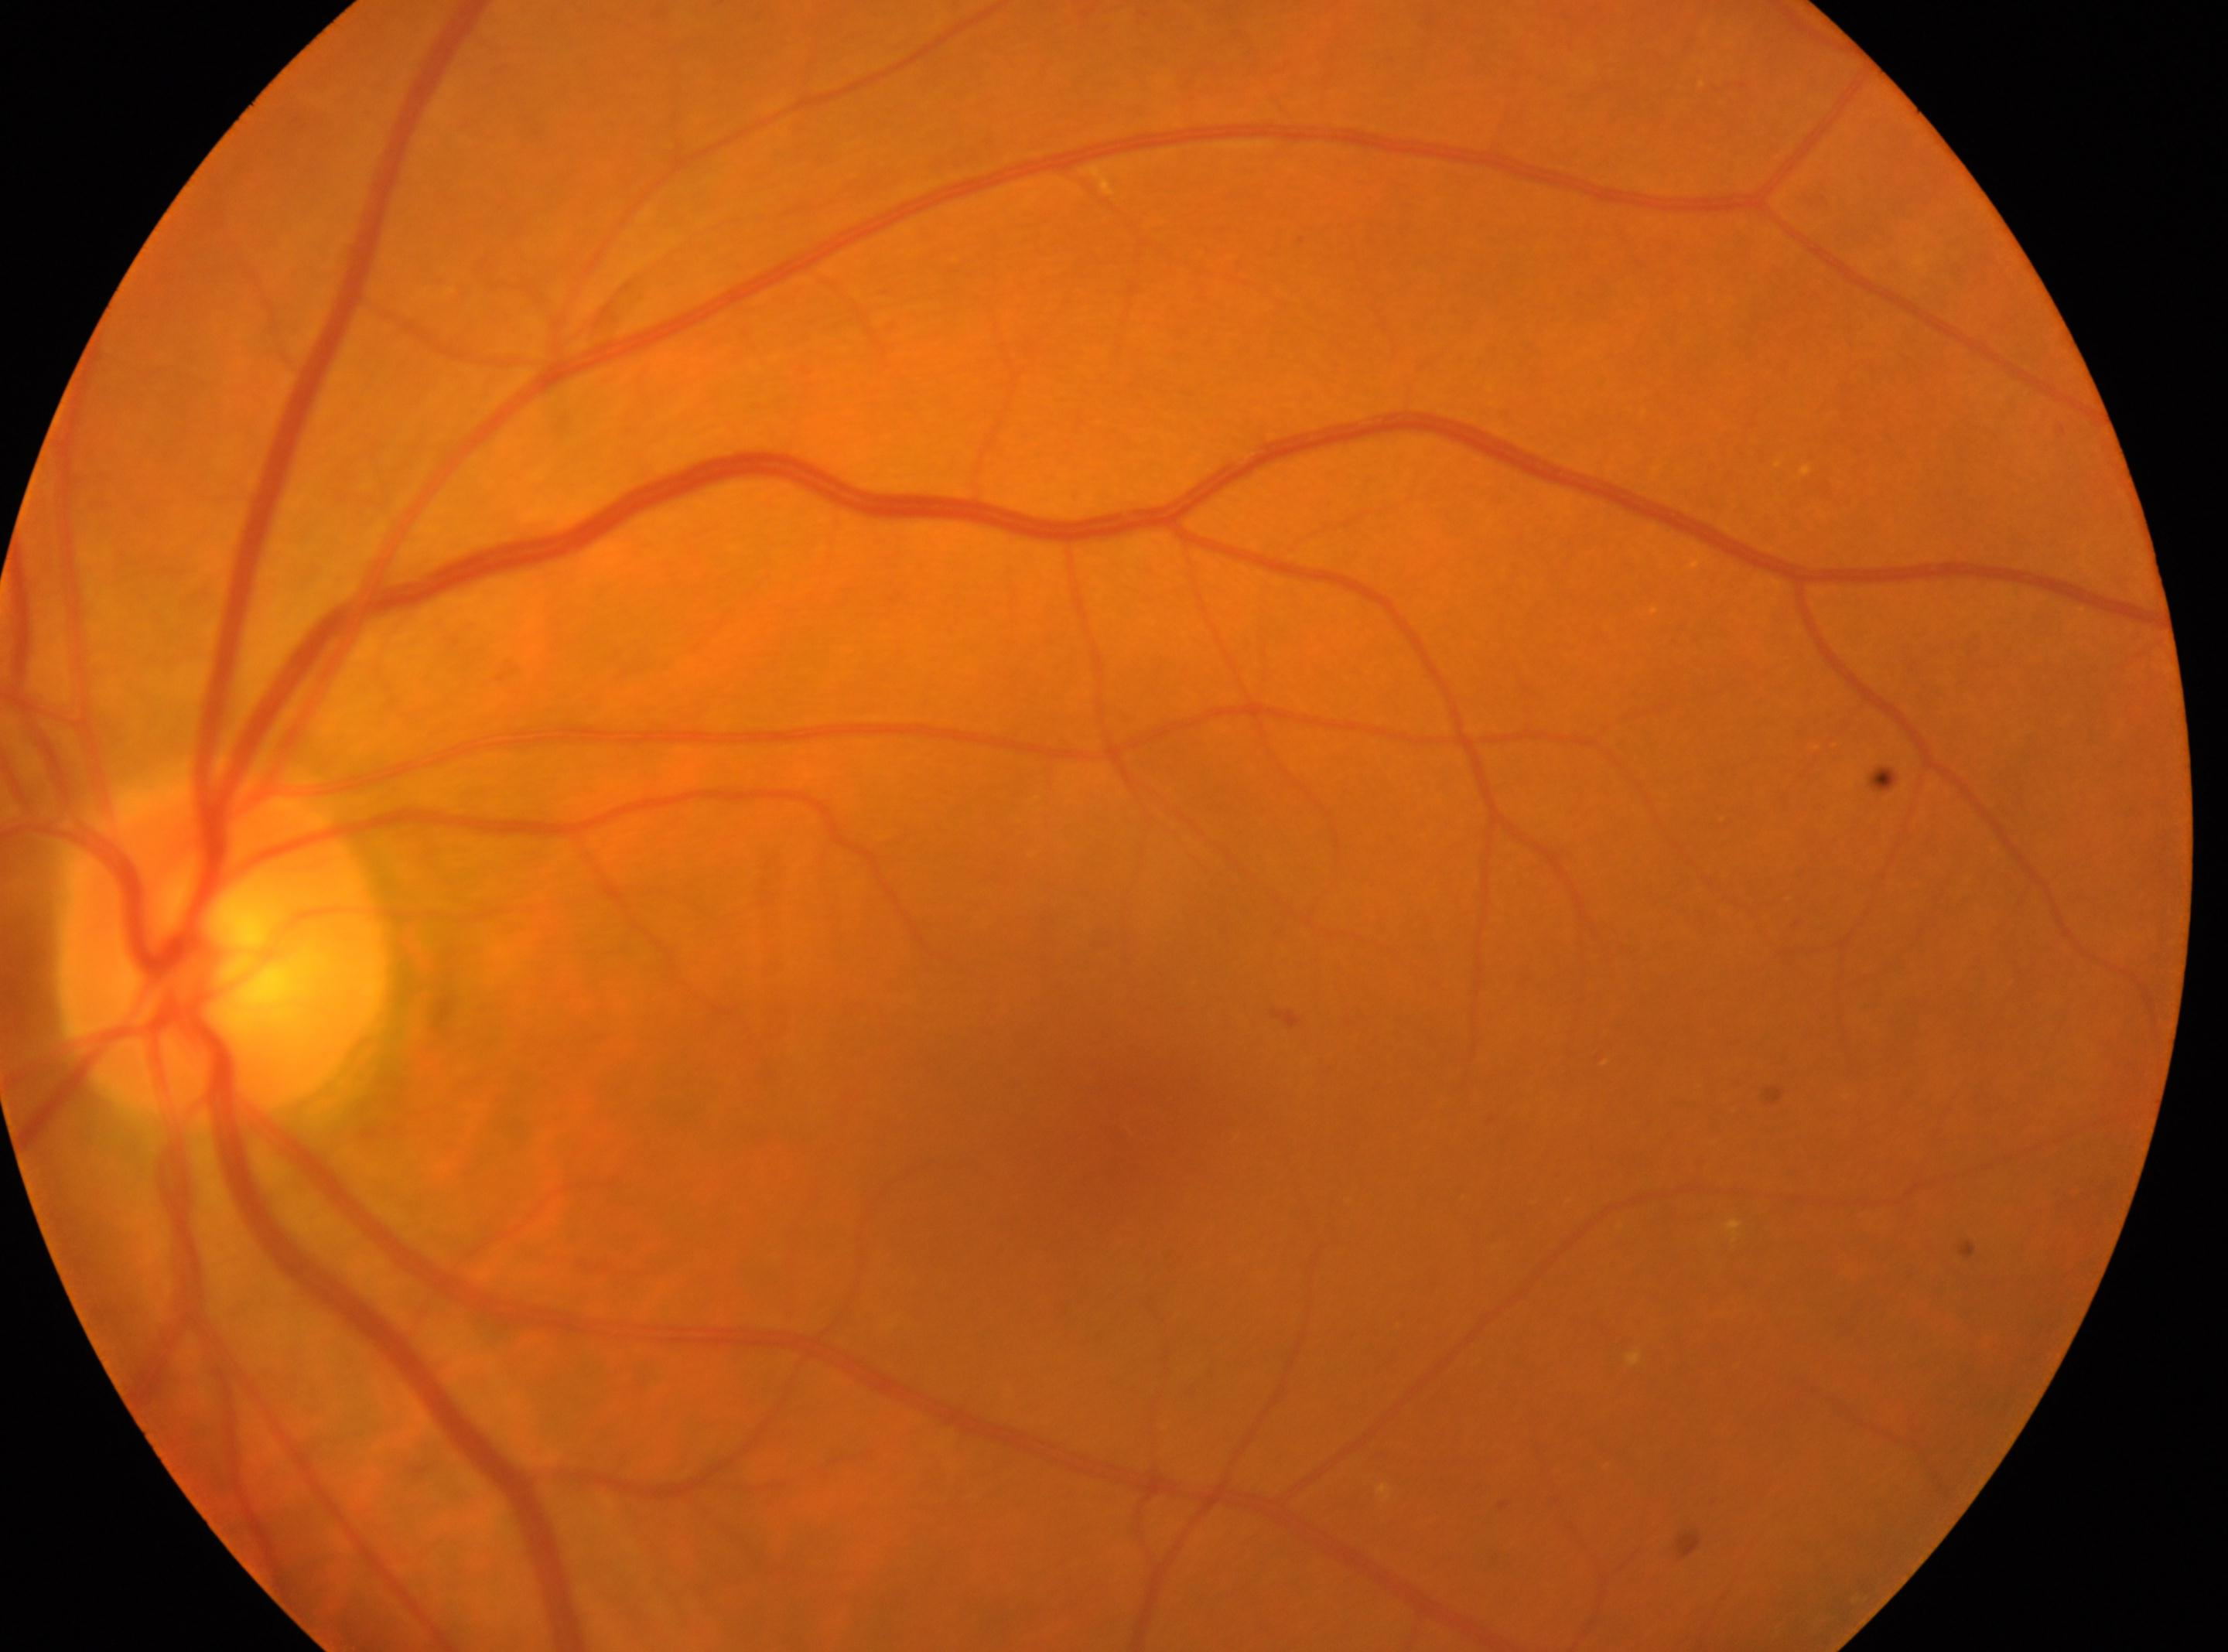
diabetic retinopathy (DR)@grade 2 (moderate NPDR) | ONH@[223, 950] | fovea center@[1142, 1126] | left.